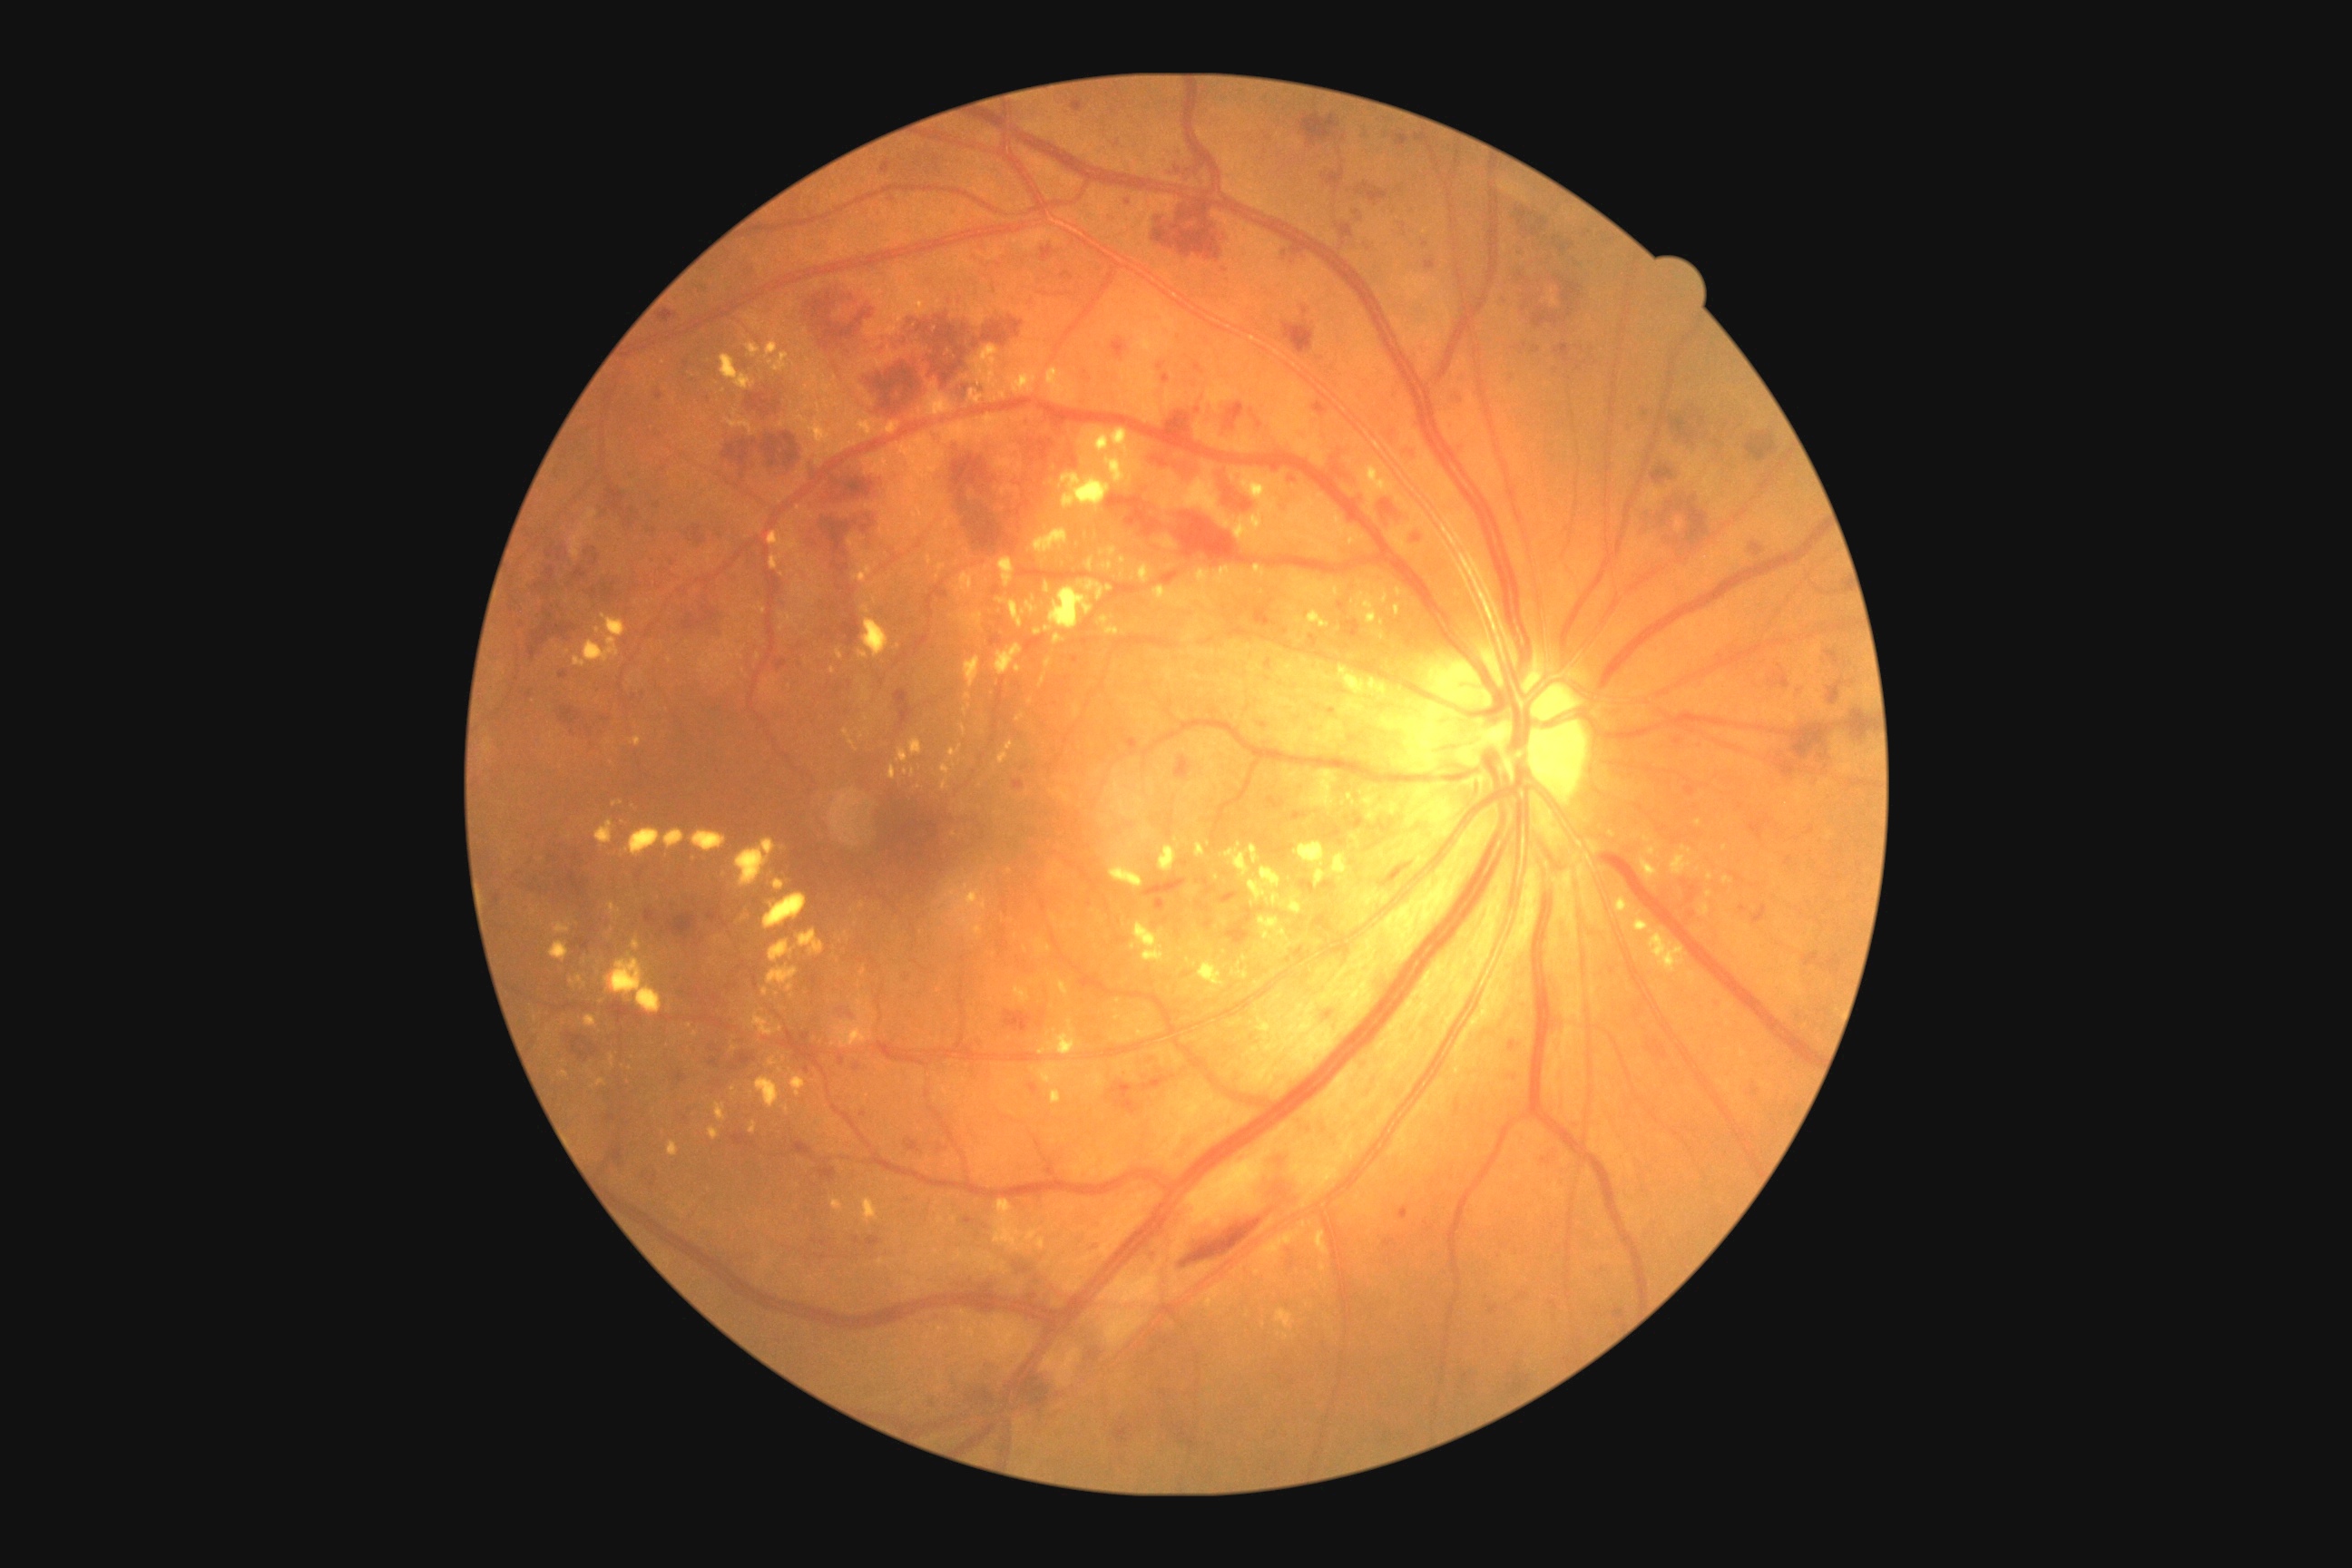 Retinopathy is severe non-proliferative diabetic retinopathy (grade 3)
A subset of detected lesions:
hard exudates (more not shown): {"left": 1059, "top": 981, "right": 1070, "bottom": 997}; {"left": 1320, "top": 1264, "right": 1326, "bottom": 1273}; {"left": 1139, "top": 564, "right": 1153, "bottom": 585}; {"left": 1130, "top": 923, "right": 1173, "bottom": 965}; {"left": 796, "top": 404, "right": 858, "bottom": 458}; {"left": 1046, "top": 368, "right": 1079, "bottom": 406}; {"left": 1073, "top": 703, "right": 1081, "bottom": 720}; {"left": 888, "top": 767, "right": 896, "bottom": 779}; {"left": 997, "top": 598, "right": 1024, "bottom": 627}; {"left": 594, "top": 819, "right": 614, "bottom": 848}; {"left": 858, "top": 418, "right": 879, "bottom": 436}; {"left": 961, "top": 725, "right": 966, "bottom": 736}; {"left": 631, "top": 937, "right": 642, "bottom": 950}; {"left": 1148, "top": 779, "right": 1155, "bottom": 790}; {"left": 843, "top": 729, "right": 856, "bottom": 747}
Small hard exudates near [1286, 1337]; [695, 1034]; [1165, 547]; [859, 984]
hemorrhages (more not shown): {"left": 1059, "top": 447, "right": 1079, "bottom": 471}; {"left": 1079, "top": 1326, "right": 1104, "bottom": 1371}; {"left": 1063, "top": 271, "right": 1073, "bottom": 282}; {"left": 1769, "top": 672, "right": 1790, "bottom": 689}; {"left": 547, "top": 545, "right": 554, "bottom": 558}; {"left": 792, "top": 1142, "right": 814, "bottom": 1161}; {"left": 1825, "top": 651, "right": 1841, "bottom": 667}; {"left": 1750, "top": 544, "right": 1765, "bottom": 558}; {"left": 1152, "top": 447, "right": 1199, "bottom": 487}; {"left": 1678, "top": 496, "right": 1709, "bottom": 547}; {"left": 1827, "top": 678, "right": 1847, "bottom": 705}; {"left": 1152, "top": 201, "right": 1224, "bottom": 262}; {"left": 965, "top": 507, "right": 1019, "bottom": 556}; {"left": 1509, "top": 1066, "right": 1514, "bottom": 1081}; {"left": 605, "top": 484, "right": 625, "bottom": 513}; {"left": 745, "top": 391, "right": 781, "bottom": 418}; {"left": 970, "top": 1279, "right": 1012, "bottom": 1298}
Small hemorrhages near [839, 588]; [1020, 485]